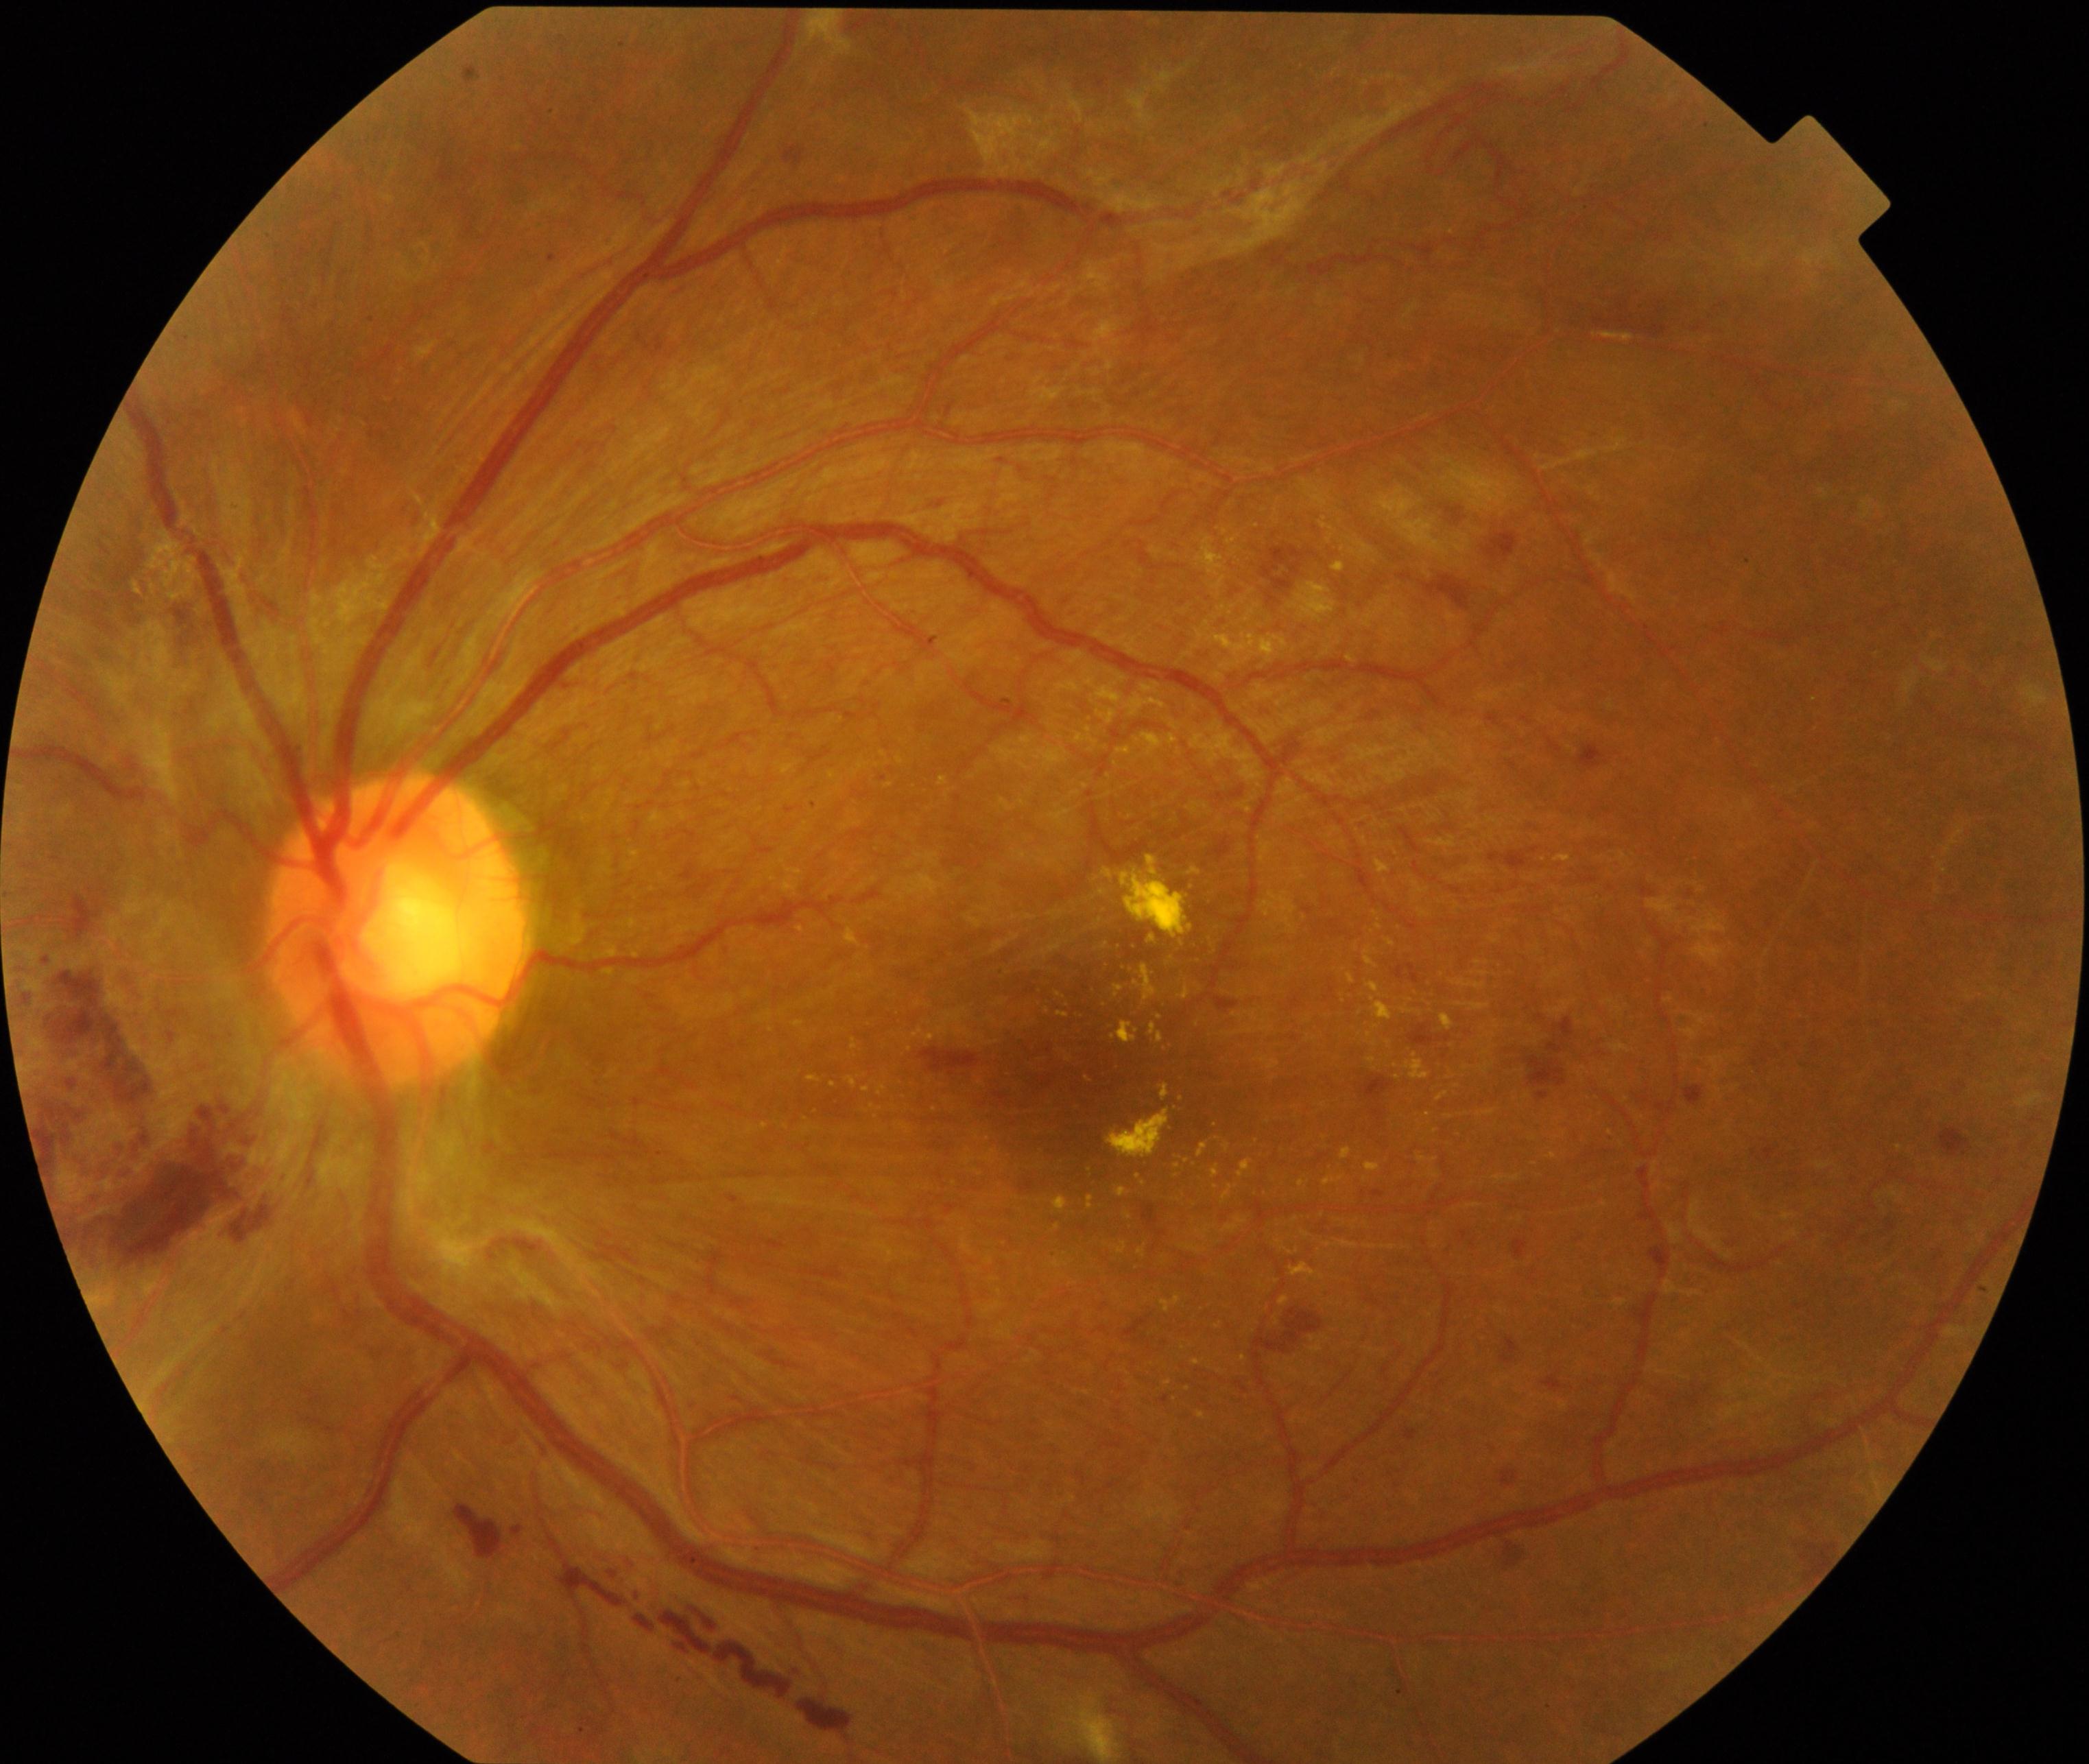

Classification: severe non-proliferative or proliferative diabetic retinopathy.